CFP. 45° field of view. 2048x1536 — 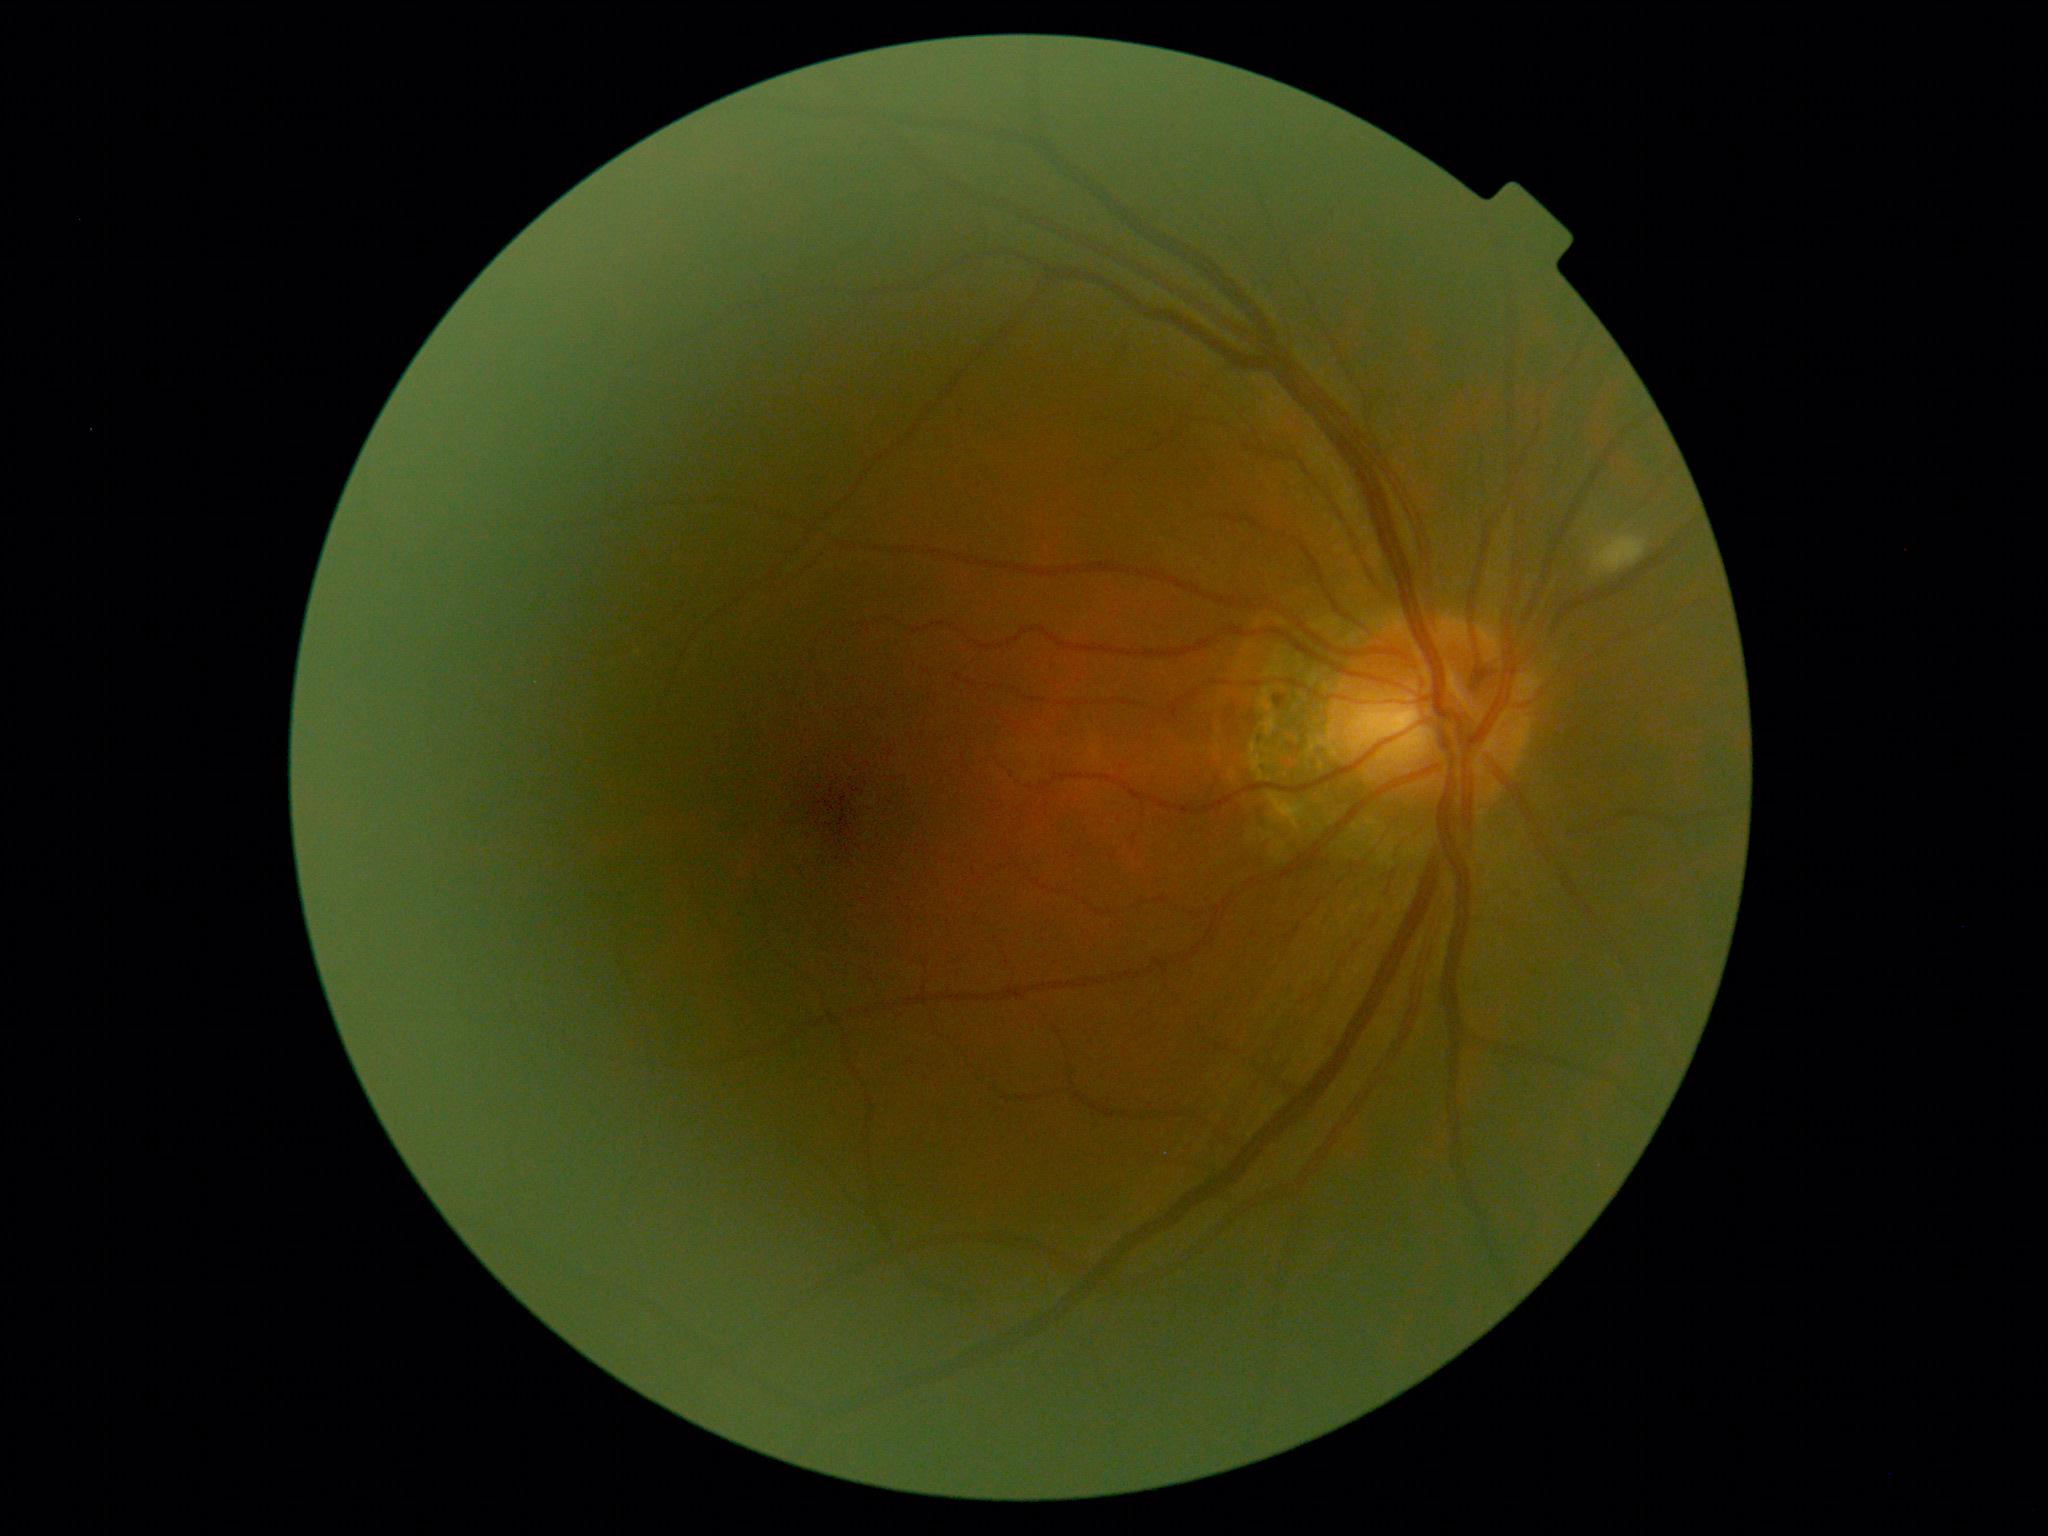

DR severity is moderate non-proliferative diabetic retinopathy (grade 2).